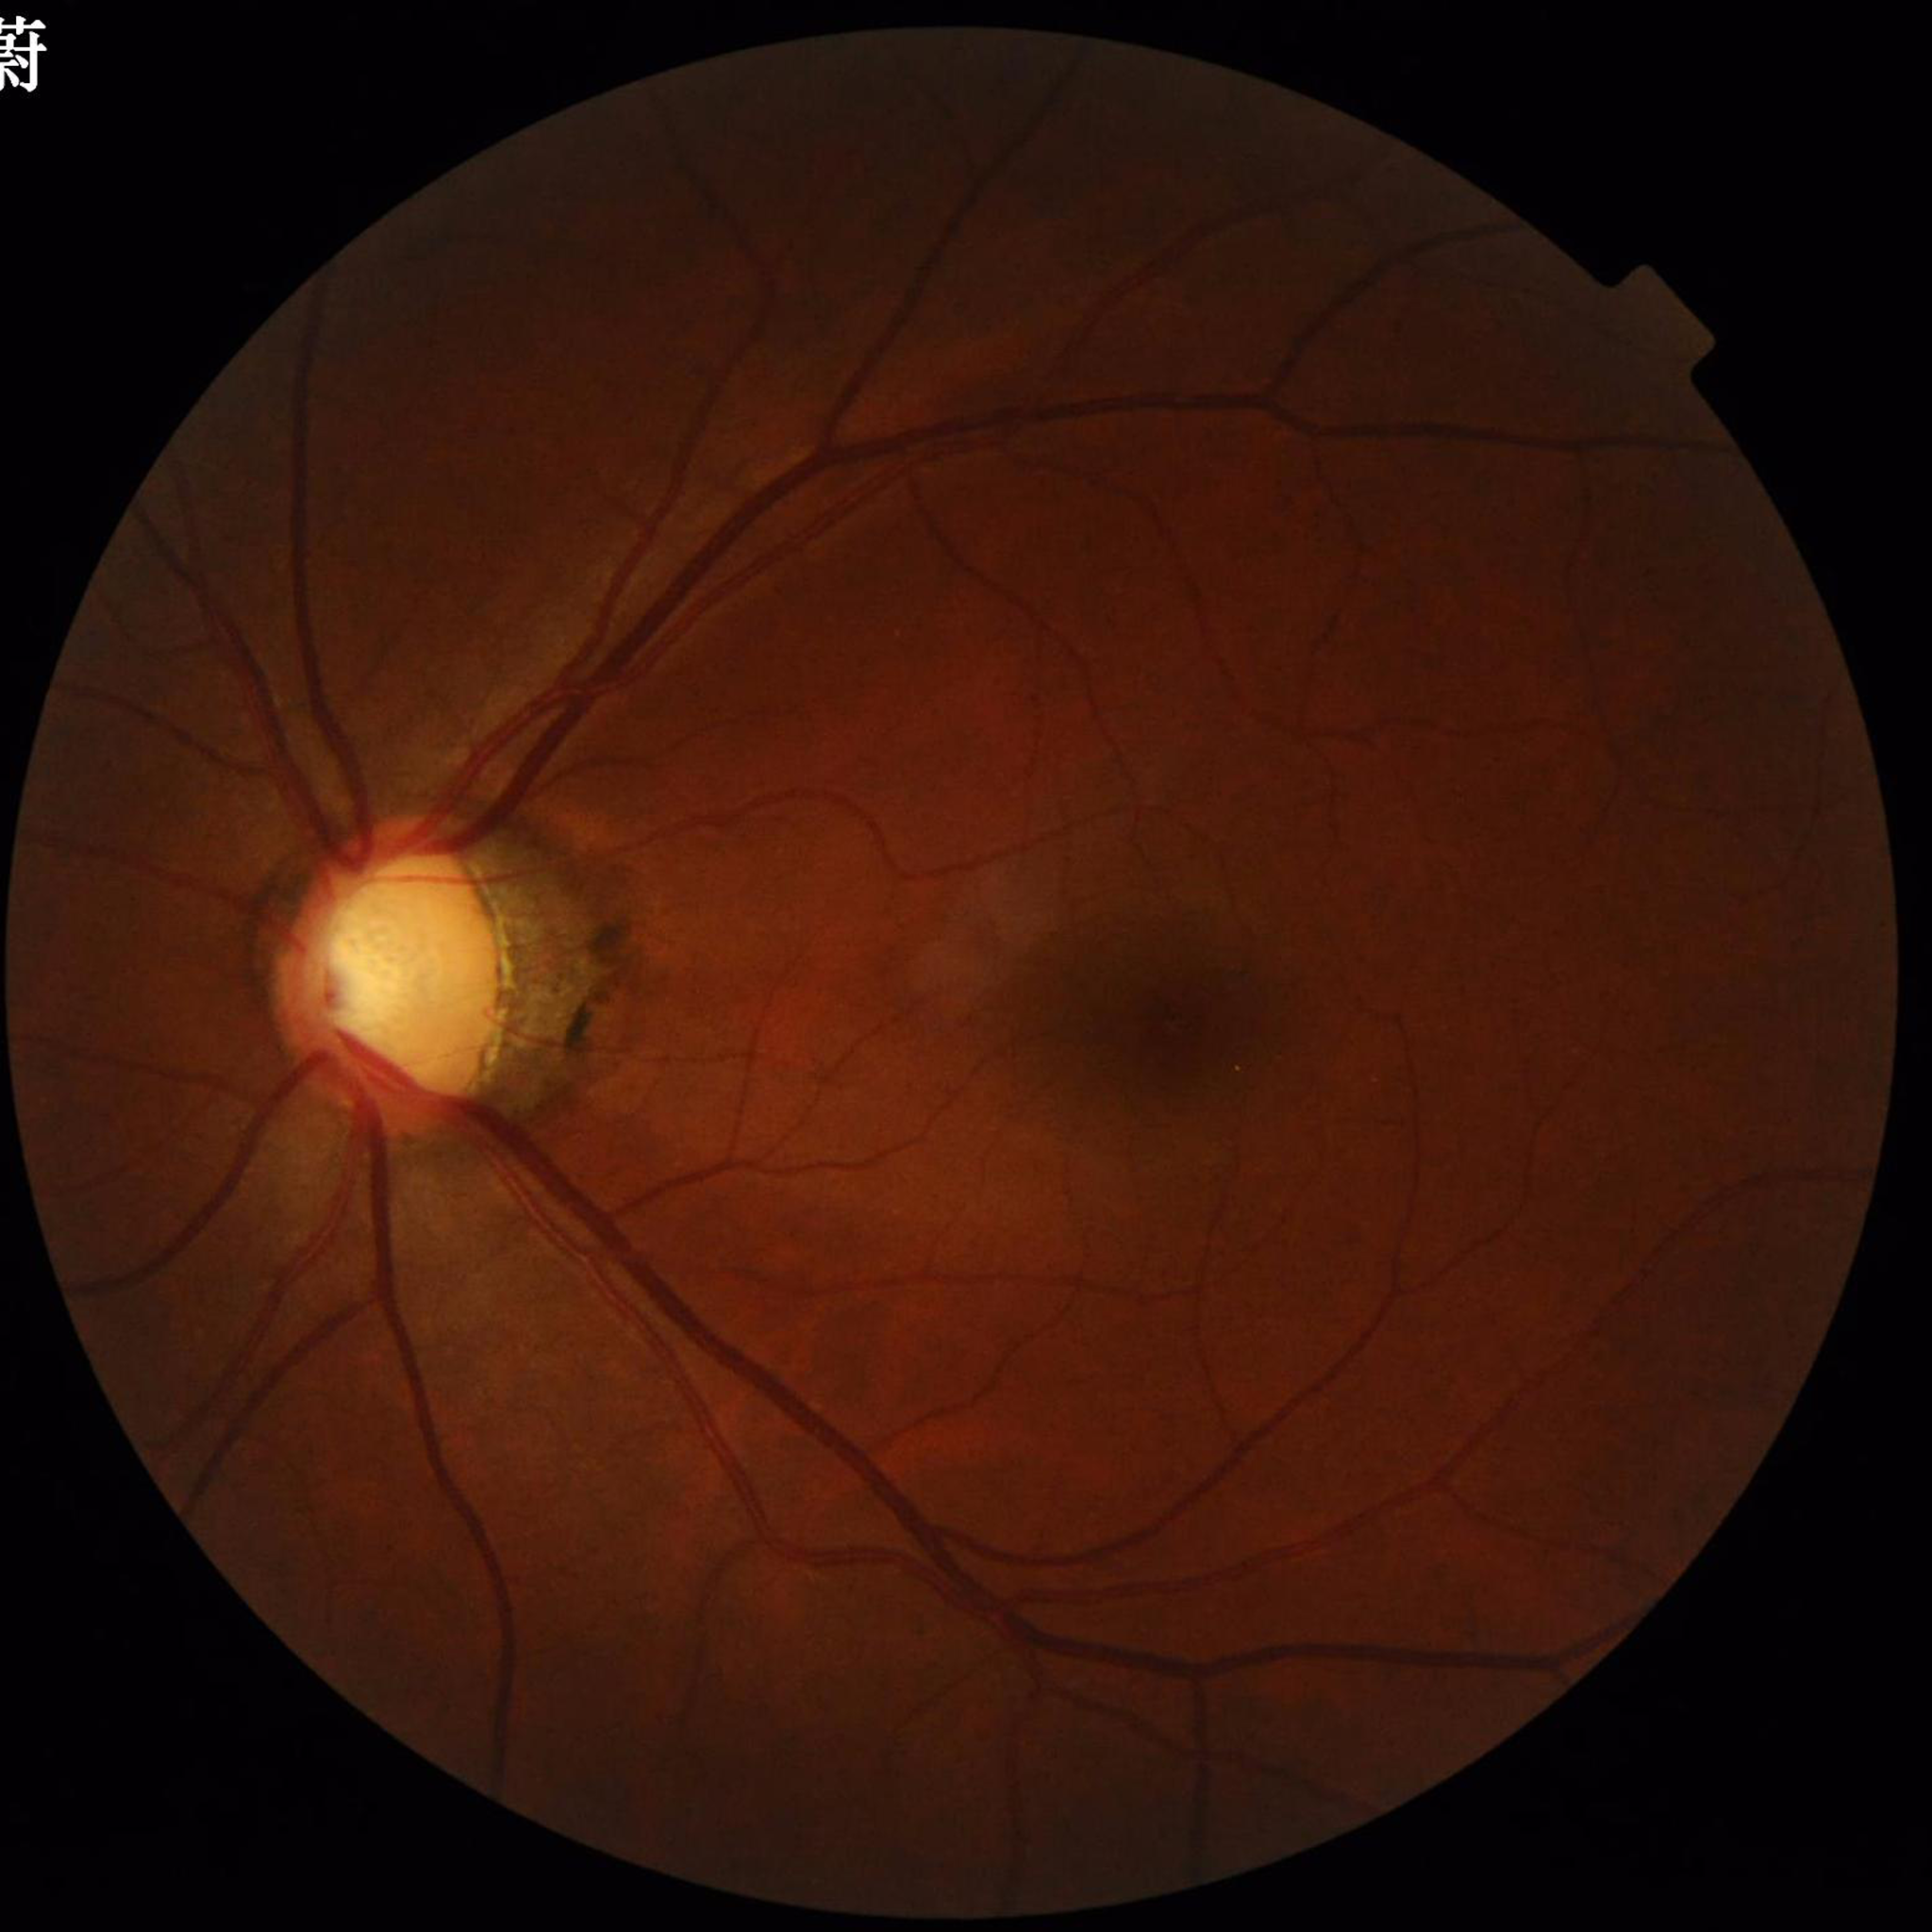
Retinal fundus photograph from a patient with glaucoma.